Pediatric wide-field fundus photograph:
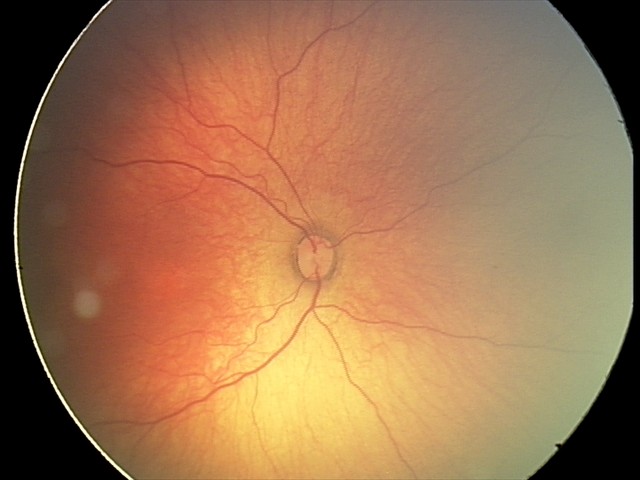 Impression: status post ROP